Retinal fundus photograph — 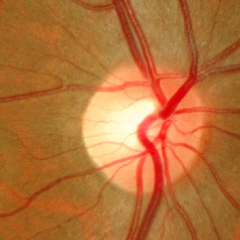
There is evidence of no evidence of glaucoma.